Ultra-widefield fundus photograph — 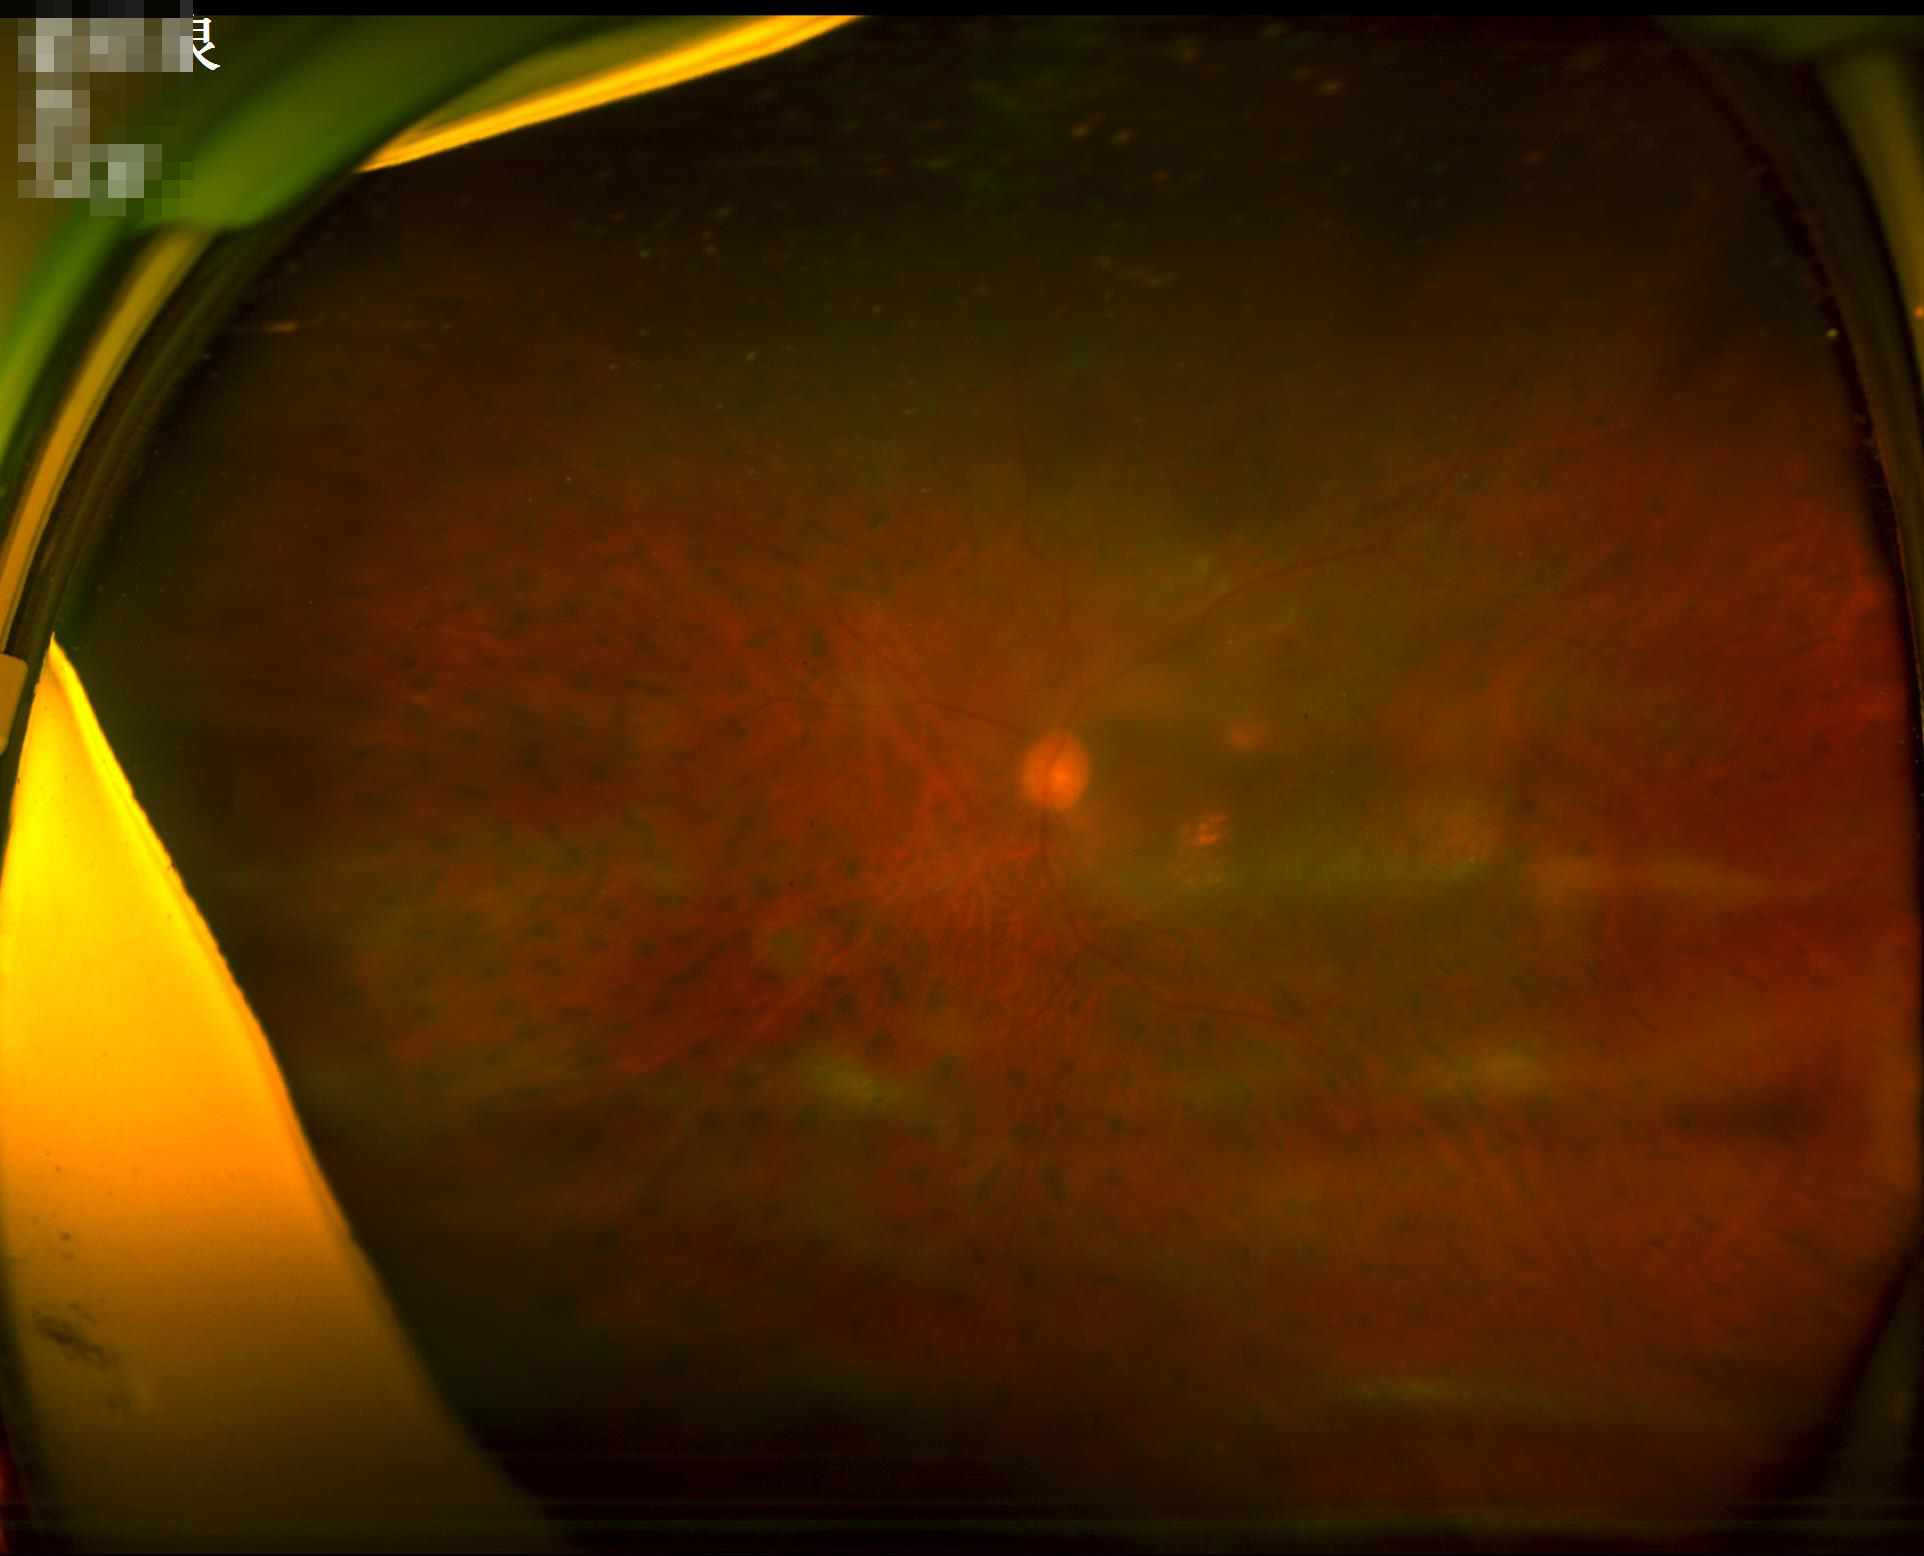

Vessels and details are readily distinguishable.
Reduced sharpness with visible blur.
Overall image quality is poor.
Illumination is uneven.